CFP:
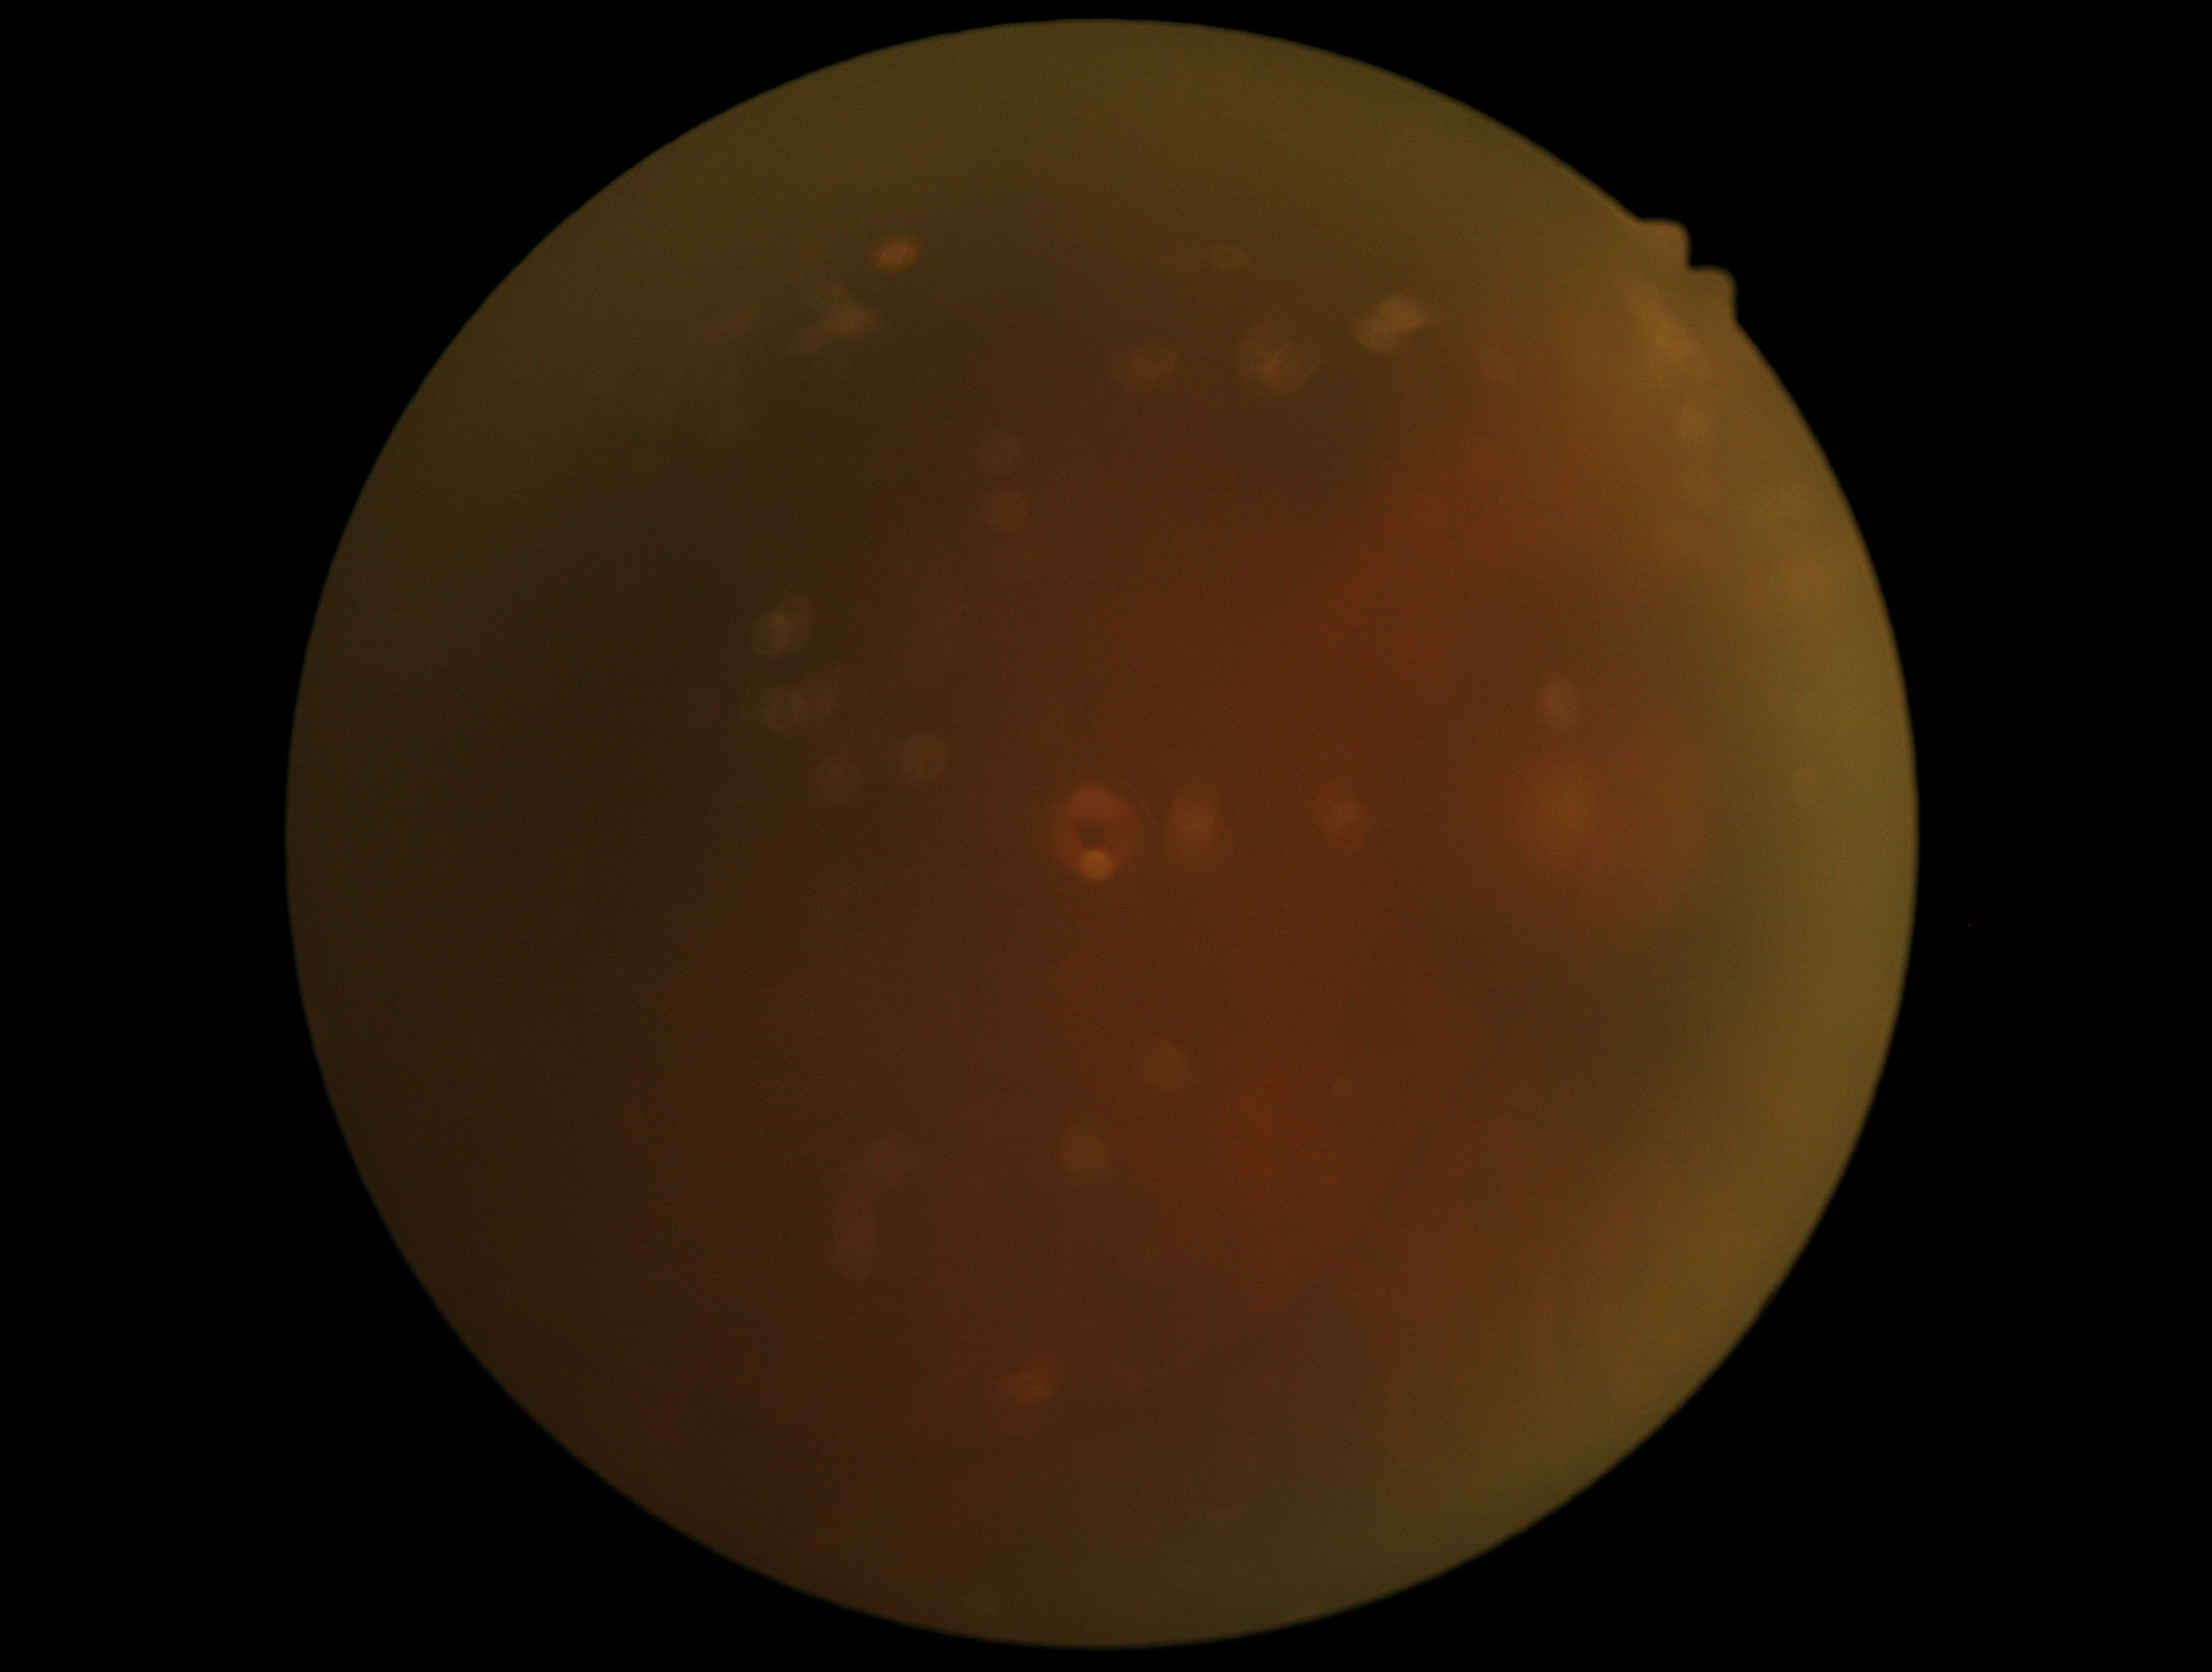

Image quality is insufficient for diabetic retinopathy assessment.
DR severity is ungradable due to poor image quality.